2352x1568px.
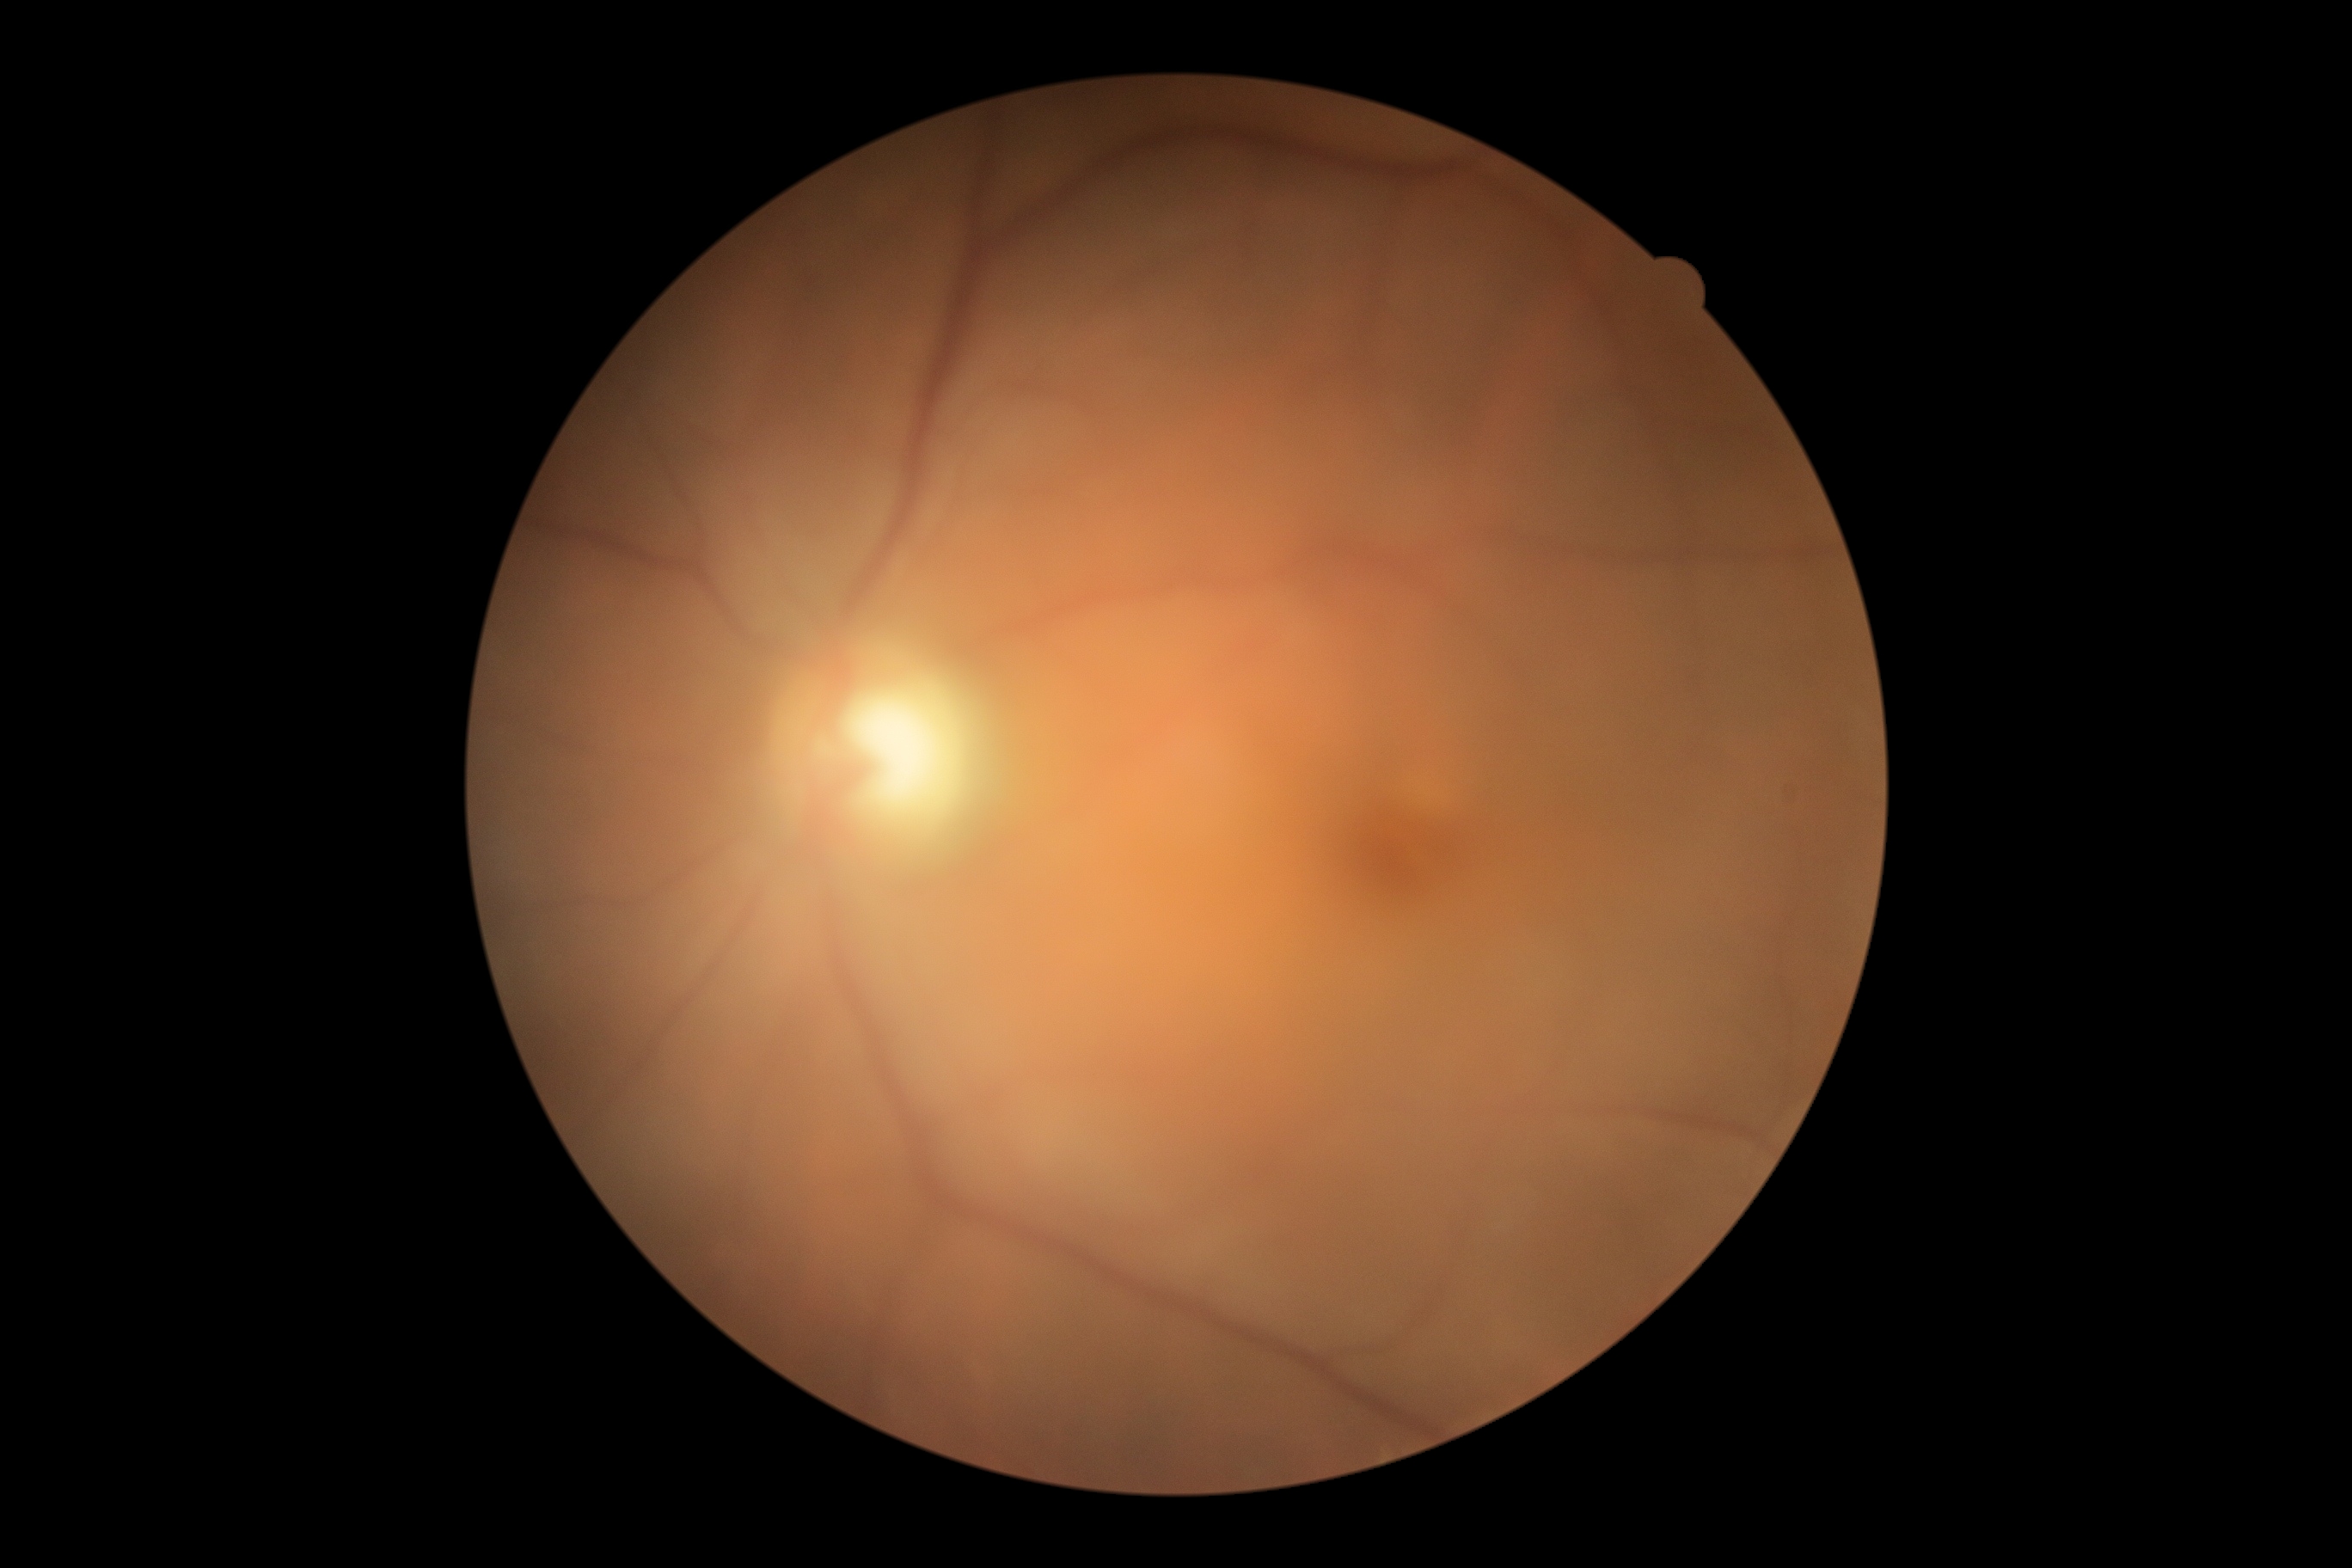
Diabetic retinopathy (DR): grade 0 (no apparent retinopathy) — no visible signs of diabetic retinopathy. No apparent diabetic retinopathy.